Captured without pupil dilation
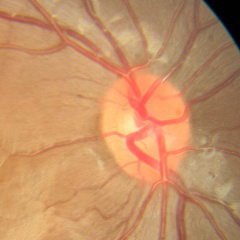
Glaucoma assessment: no signs of glaucoma.